Retinal fundus photograph · 2212x1659px: 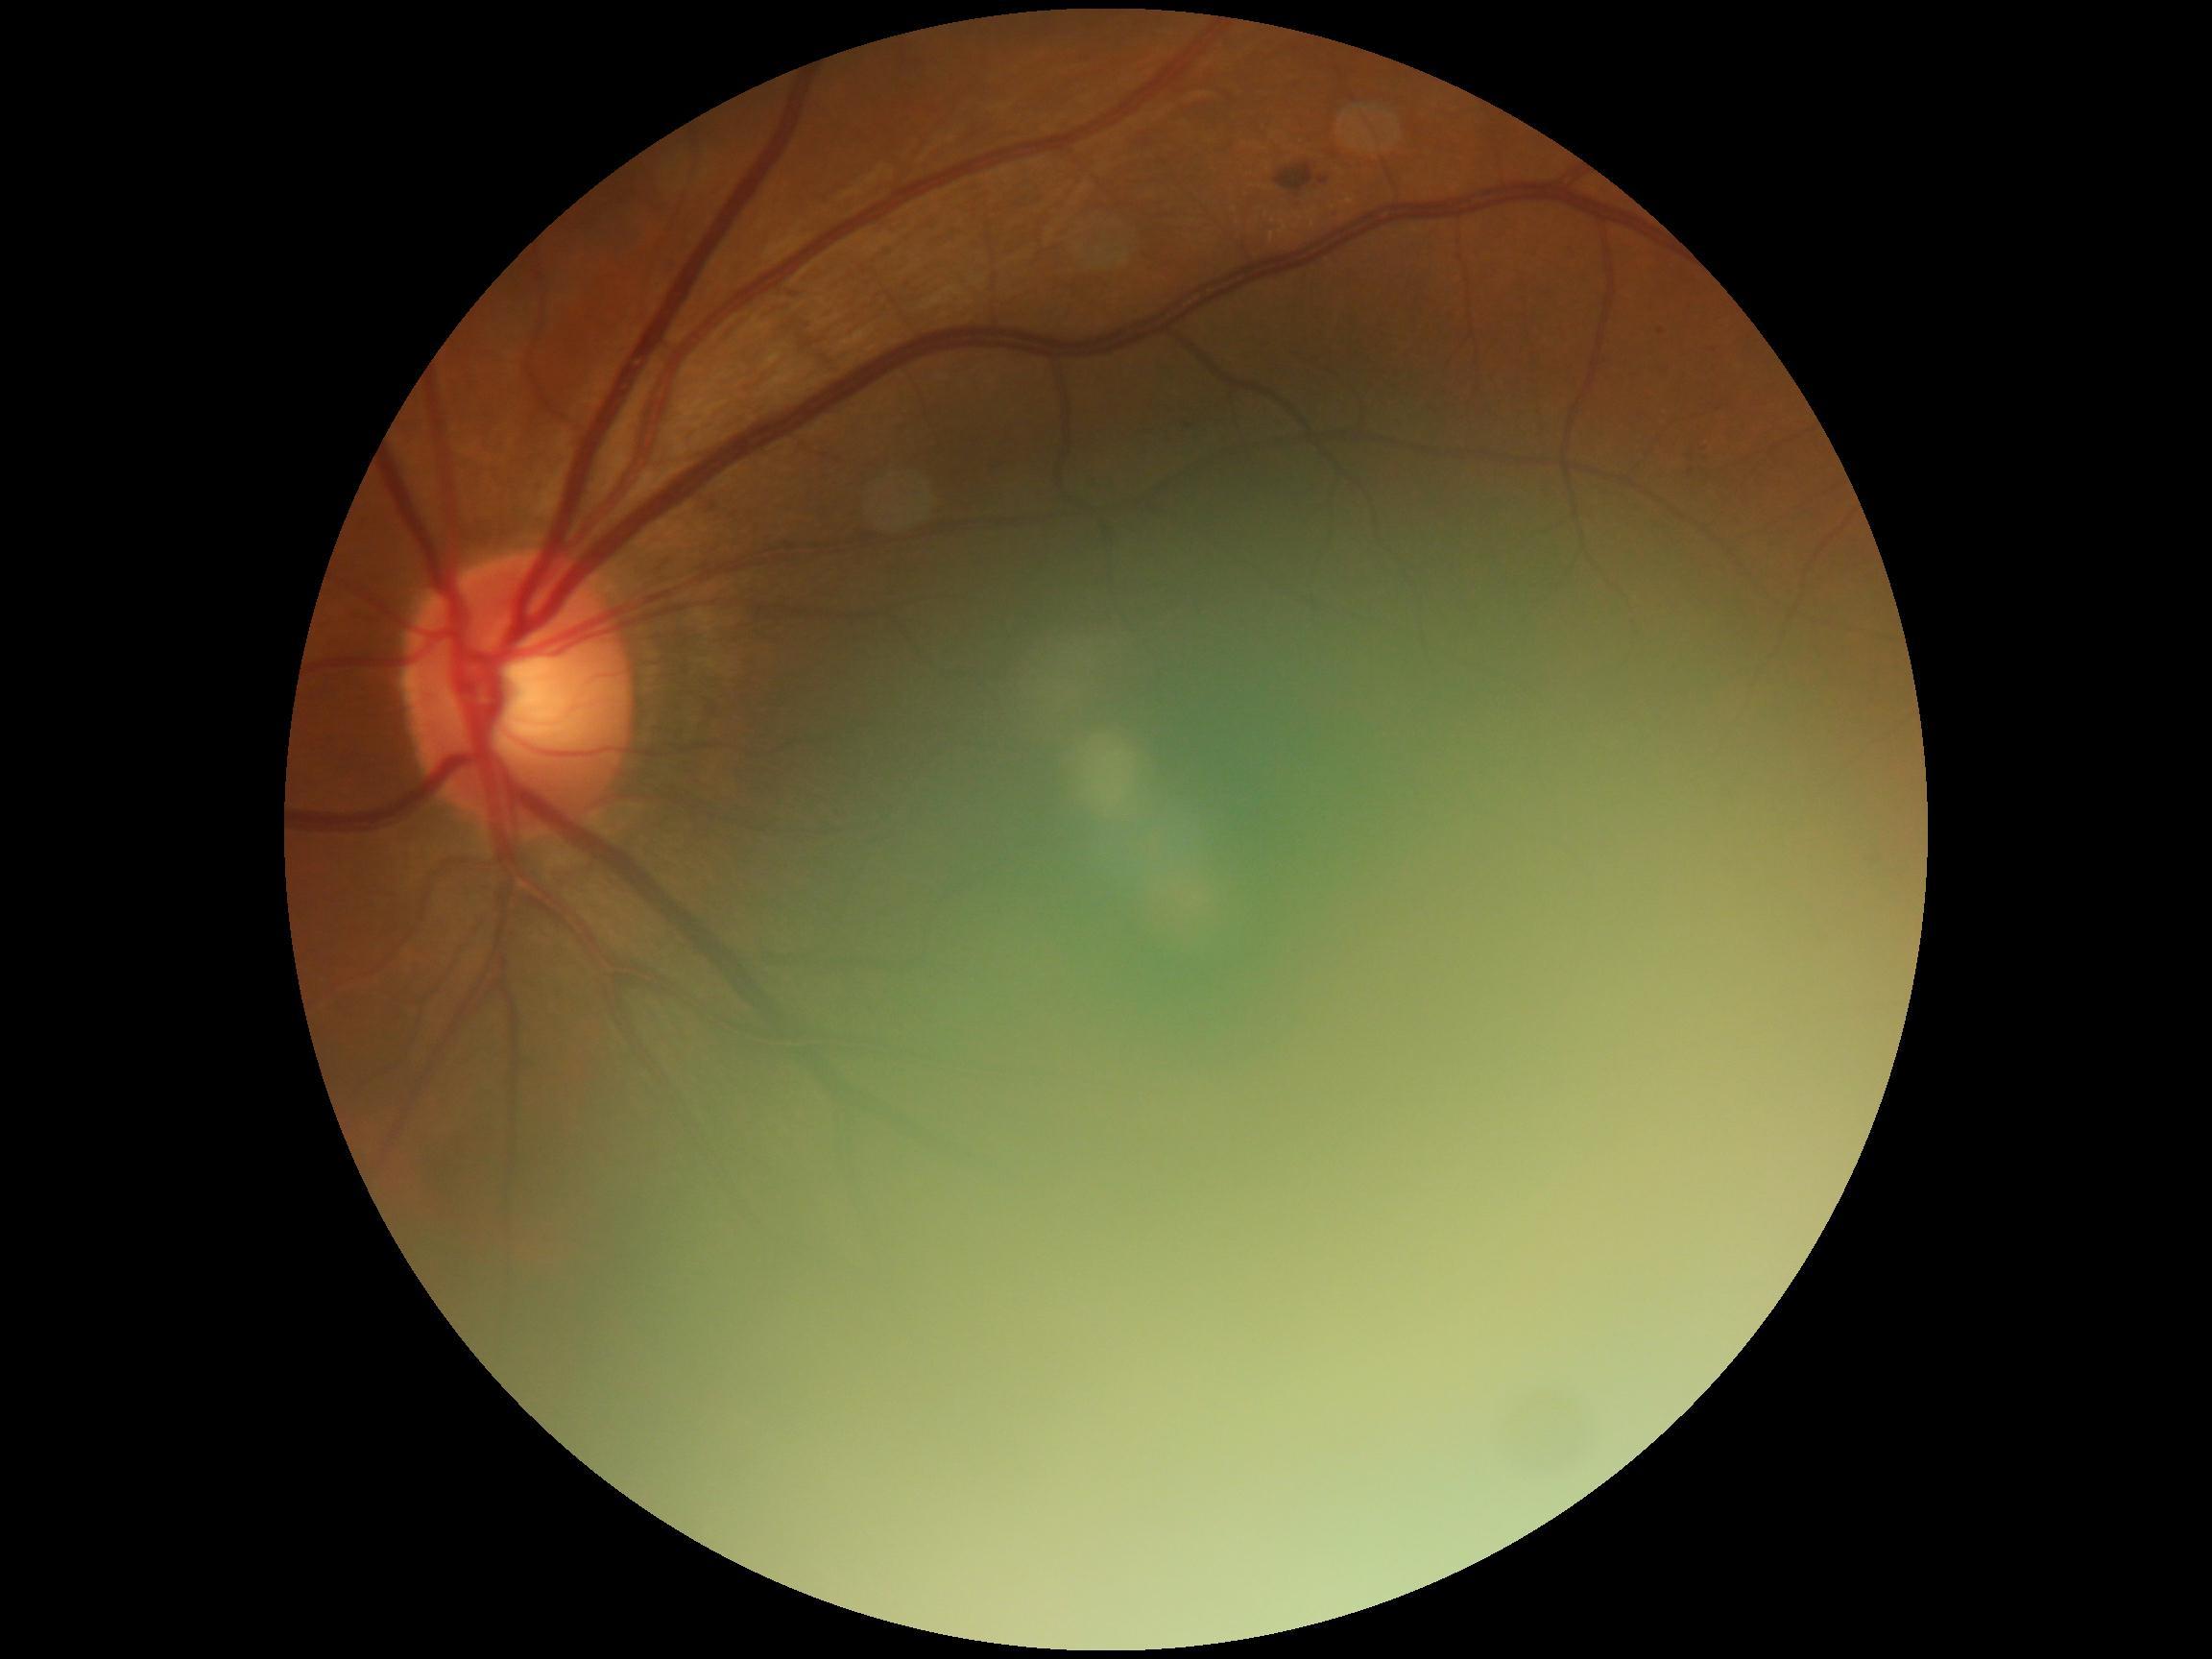 Annotations:
* retinopathy grade — 2 — more than just microaneurysms but less than severe NPDR
* DR class — non-proliferative diabetic retinopathy